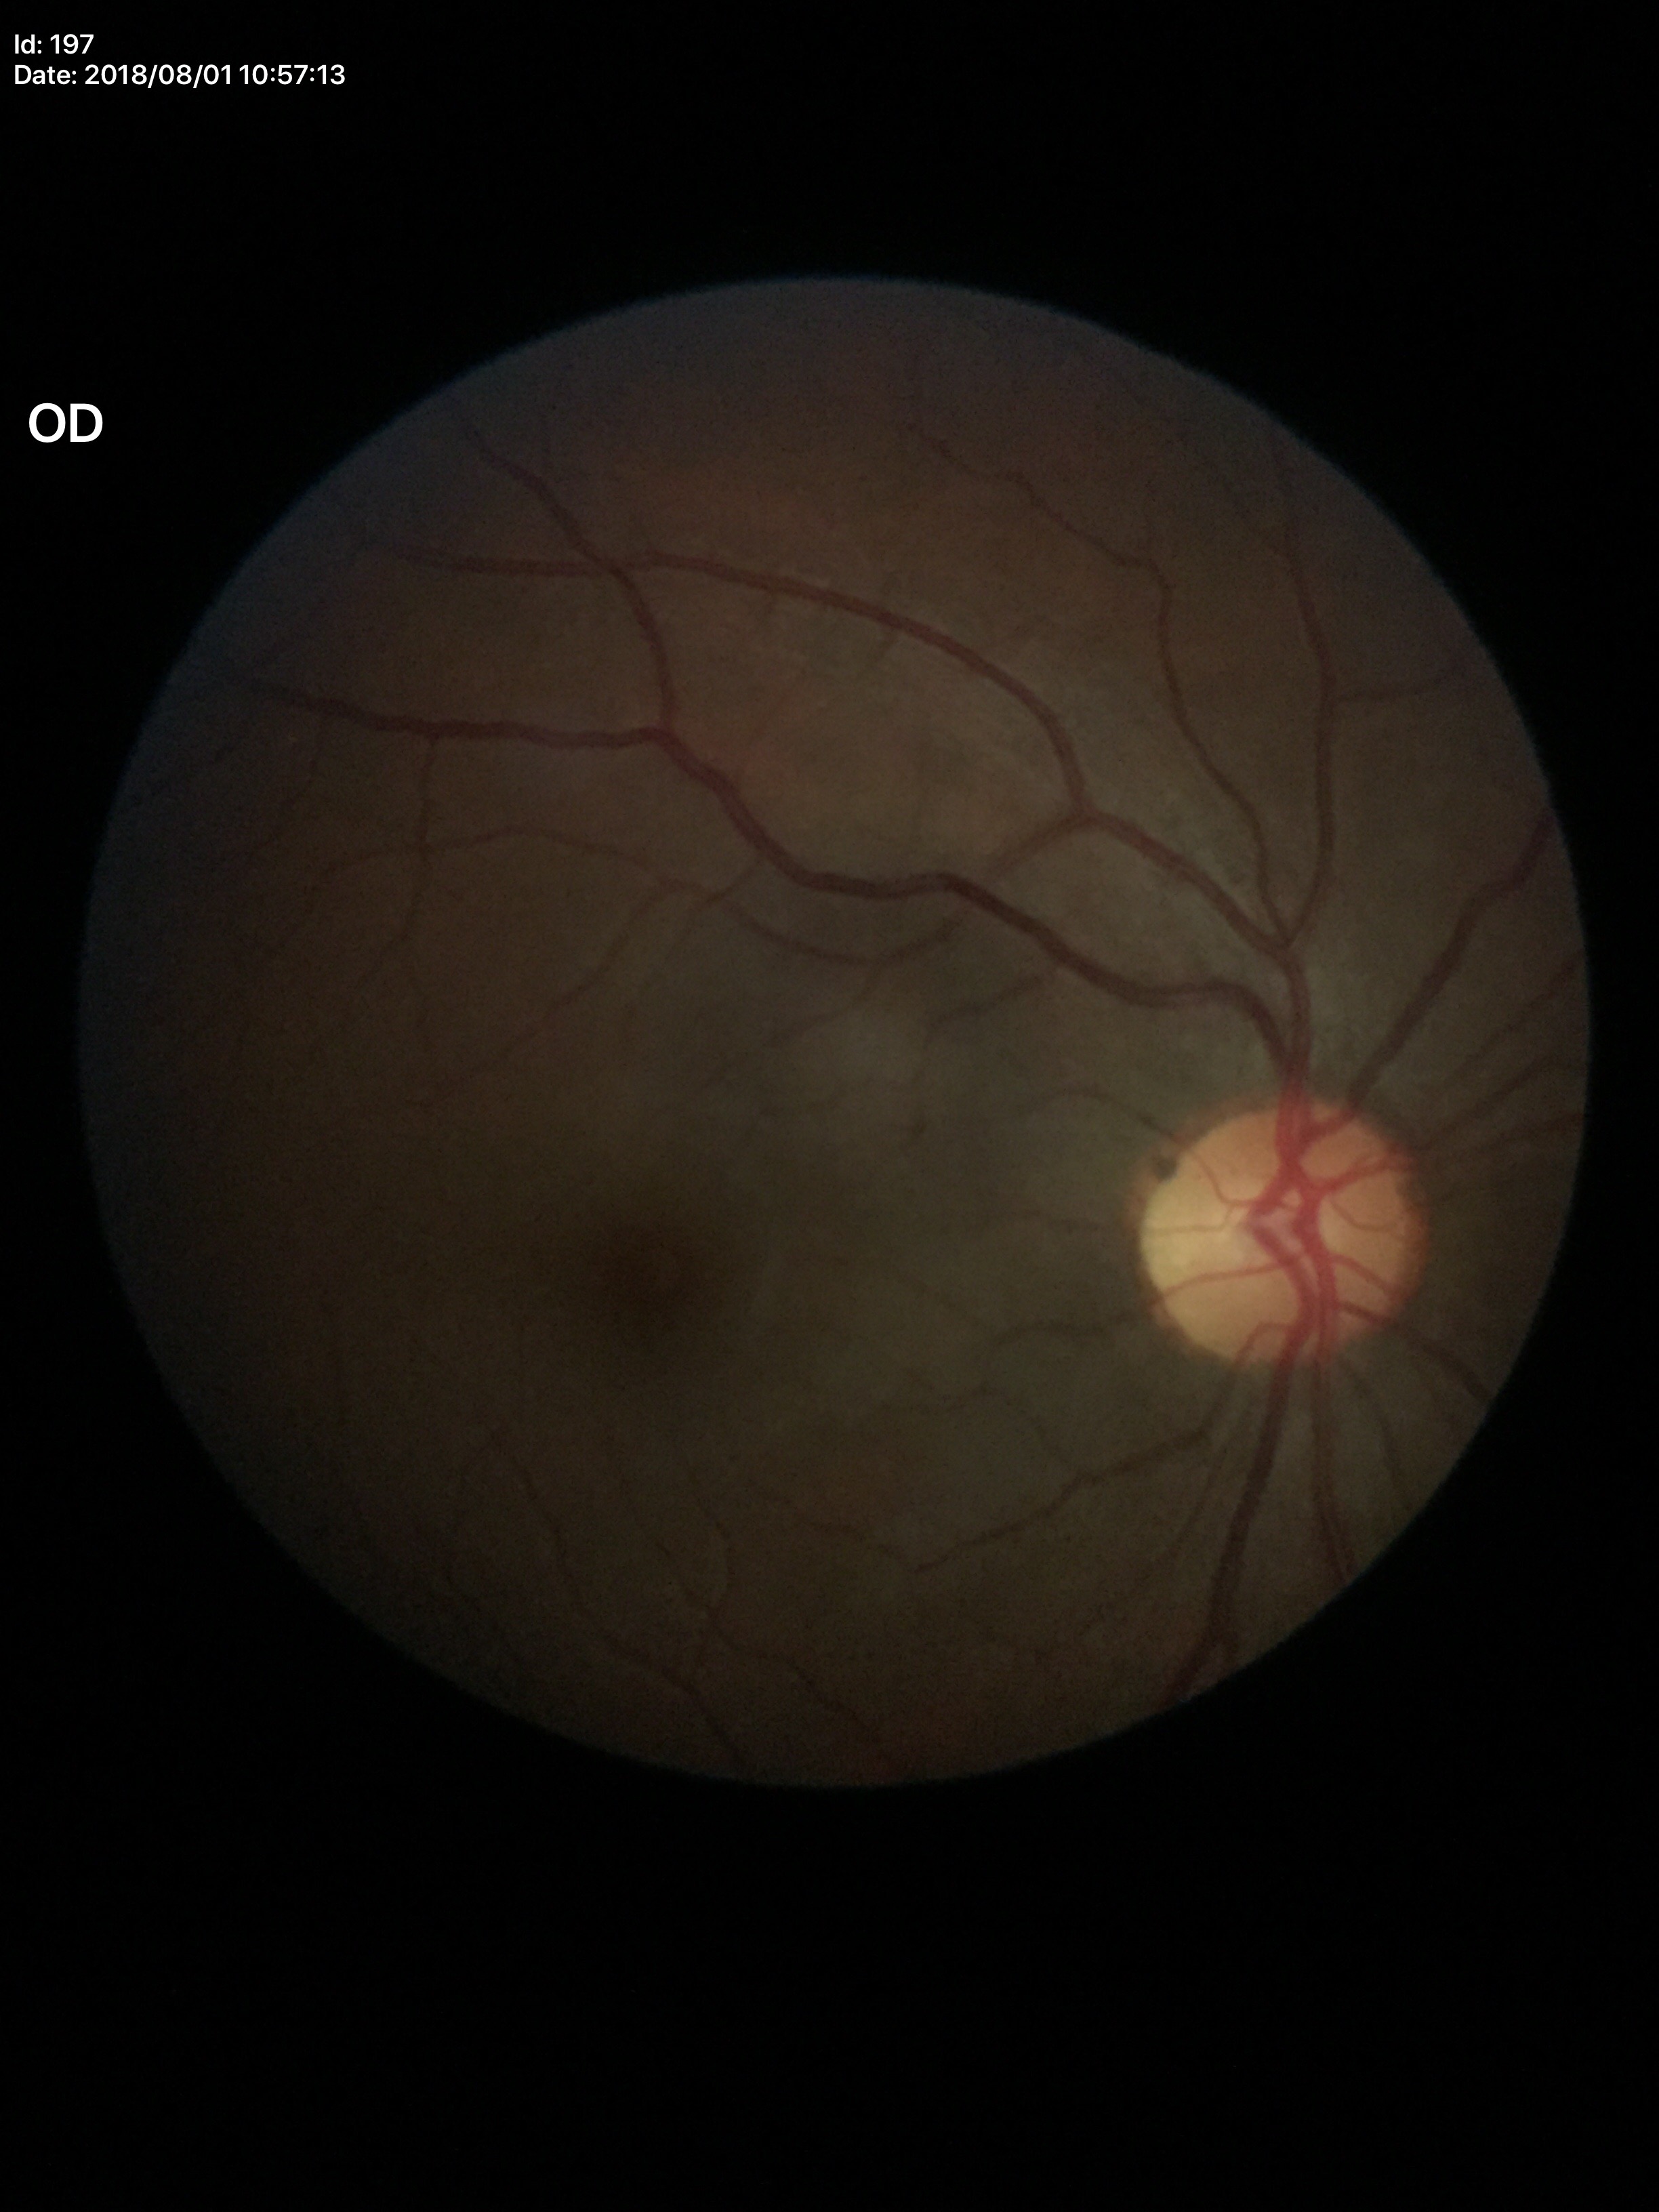

Glaucoma evaluation=negative | VCDR=0.46